RetCam wide-field infant fundus image. 1440 by 1080 pixels.
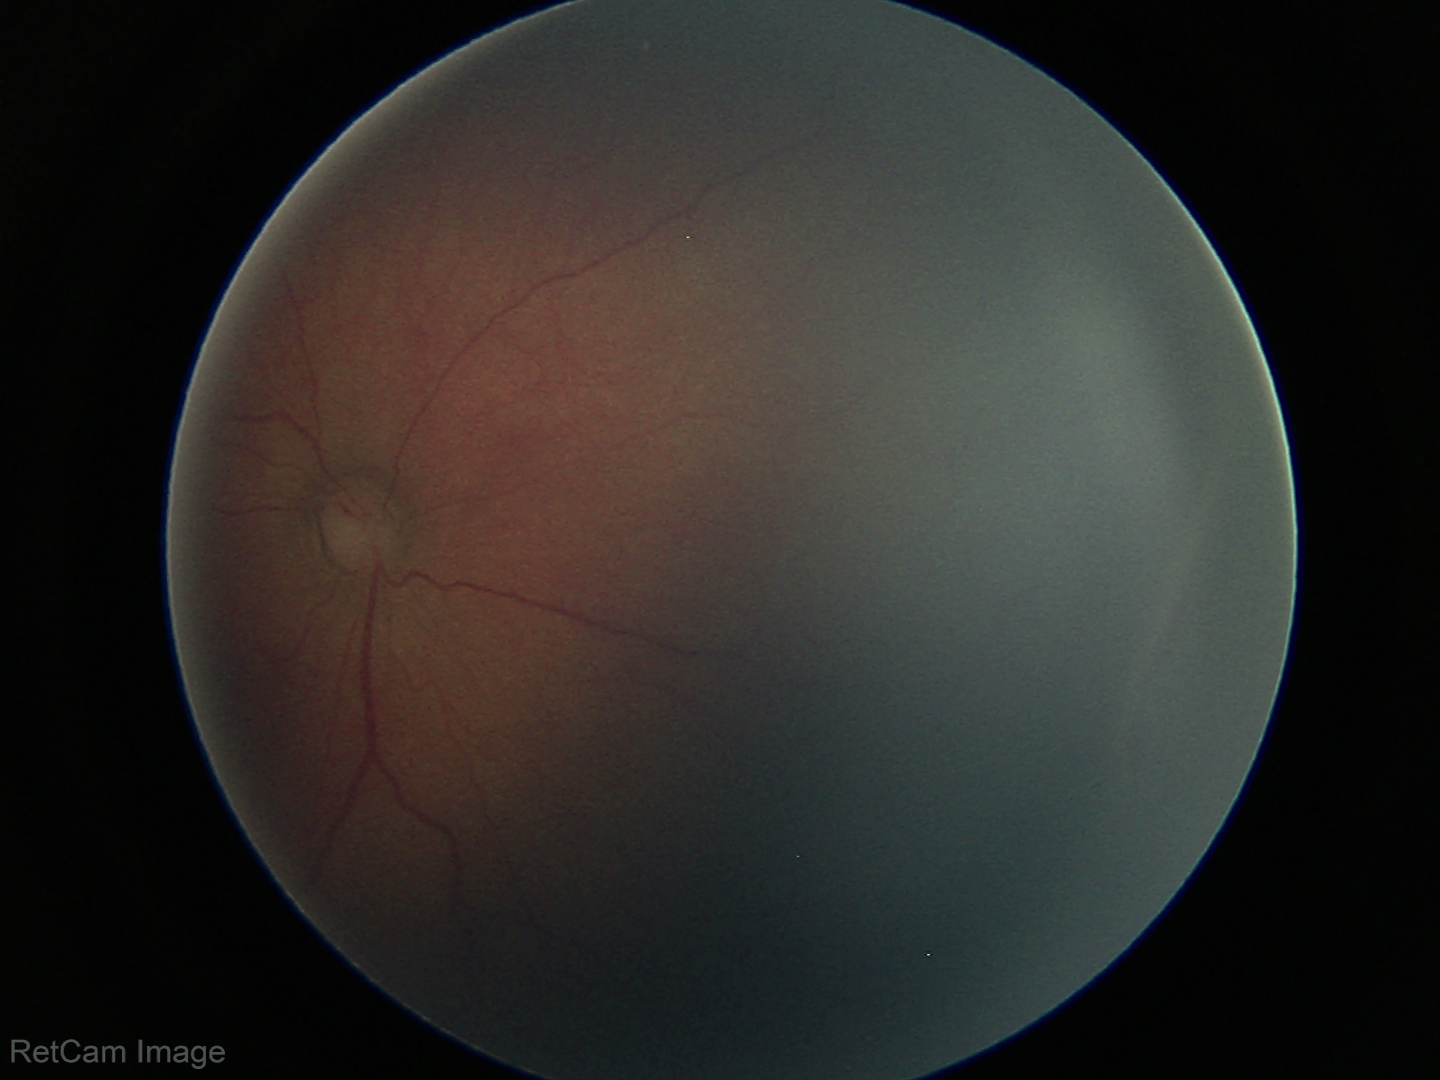

Without plus disease.
From an examination with diagnosis of ROP stage 2.